2361 x 1568 pixels. Fundus photo. Kowa VX-10α. 50° field of view. Captured after pupil dilation. Macula-centered field
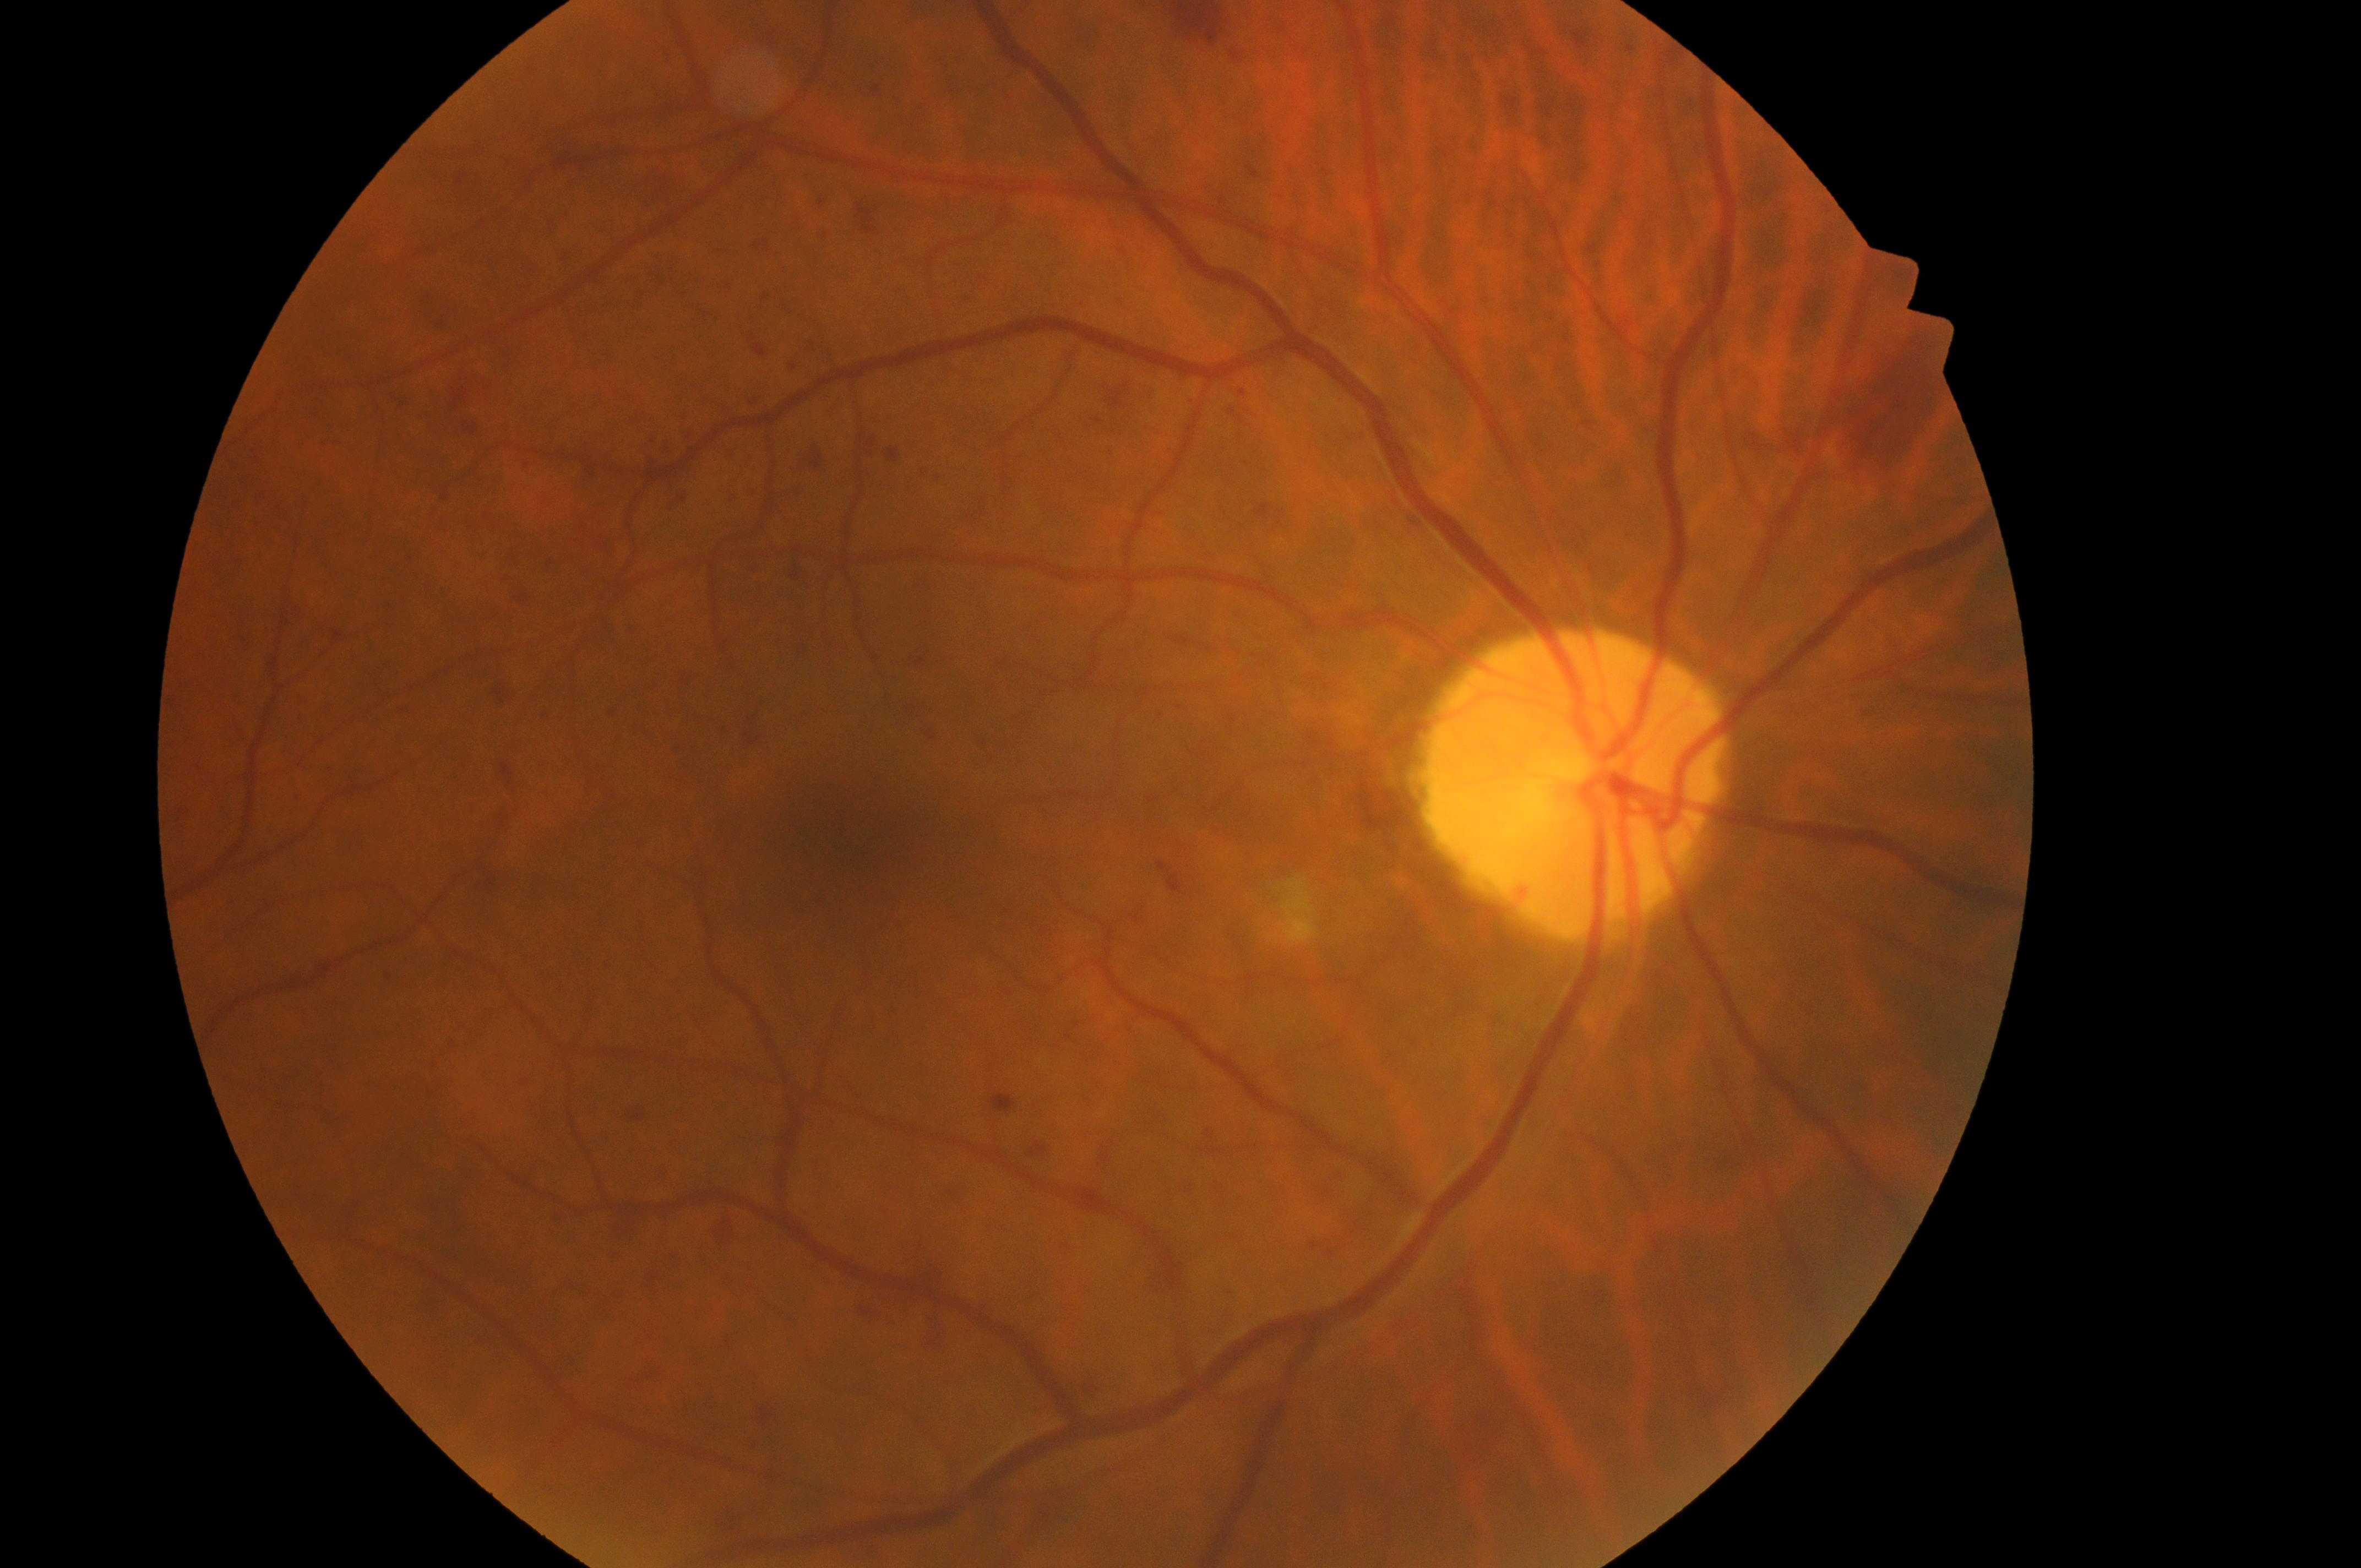 | feature | annotation |
|---|---|
| laterality | right |
| macular edema | 0 |
| the optic disc | 1572px, 783px |
| the fovea | 827px, 835px |
| retinopathy | 3/4 |